Modified Davis grading, 45 degree fundus photograph, NIDEK AFC-230 fundus camera, without pupil dilation.
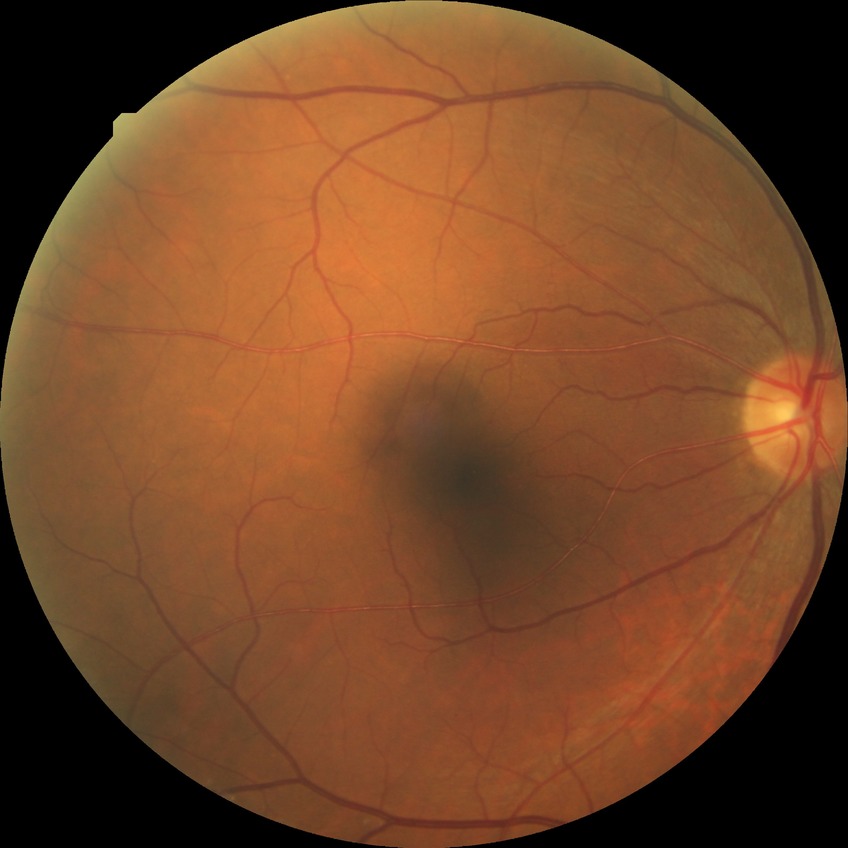   davis_grade: SDR